1380 x 1382 pixels, FOV: 45 degrees.
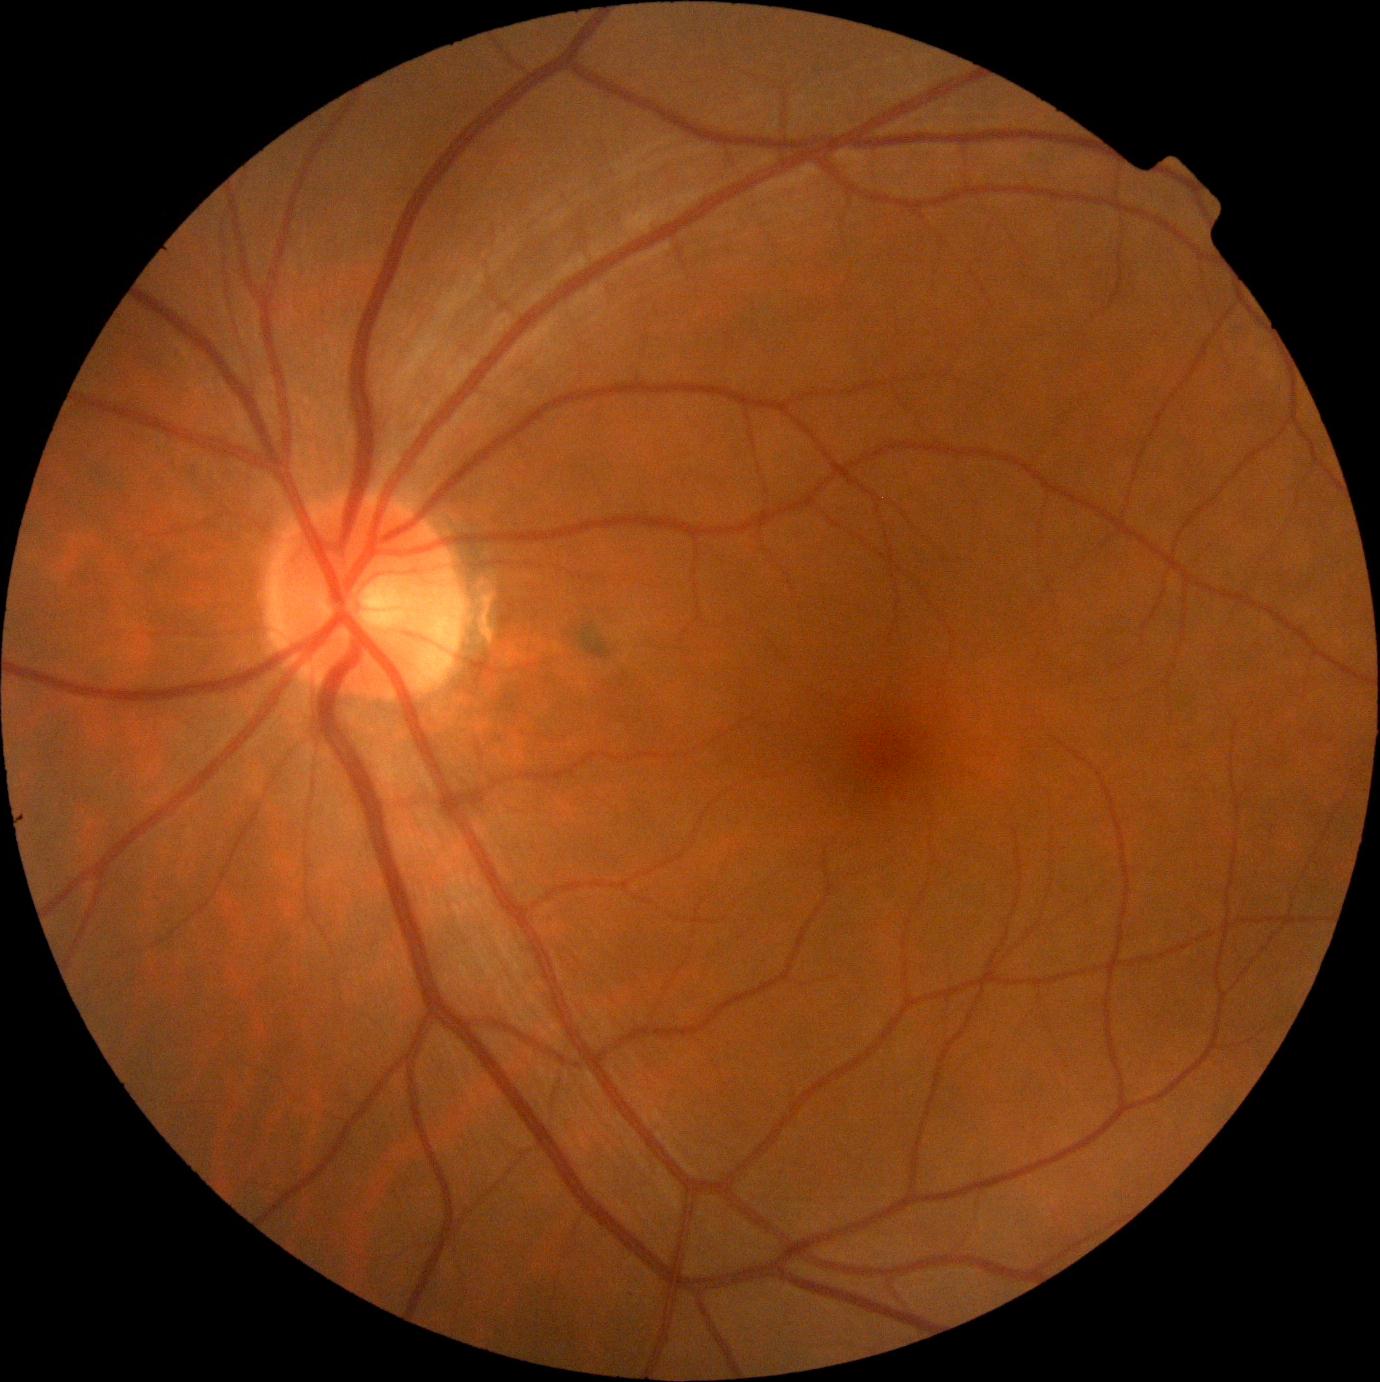
Diabetic retinopathy grade is 0/4.